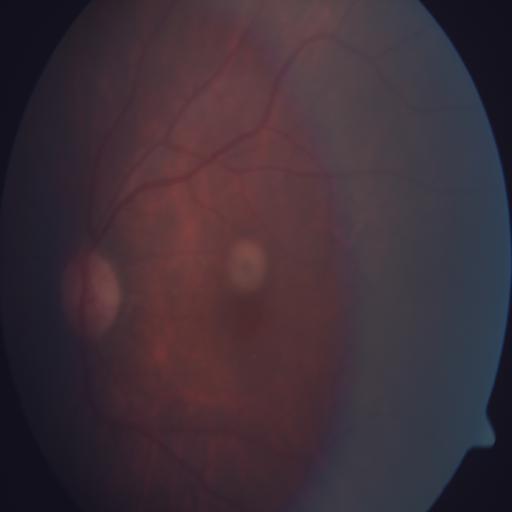
Fundus appearance consistent with tessellation.